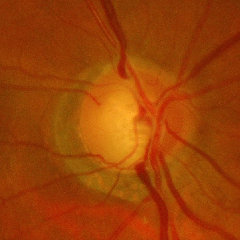
Glaucomatous optic neuropathy is present.
Advanced-stage glaucoma.